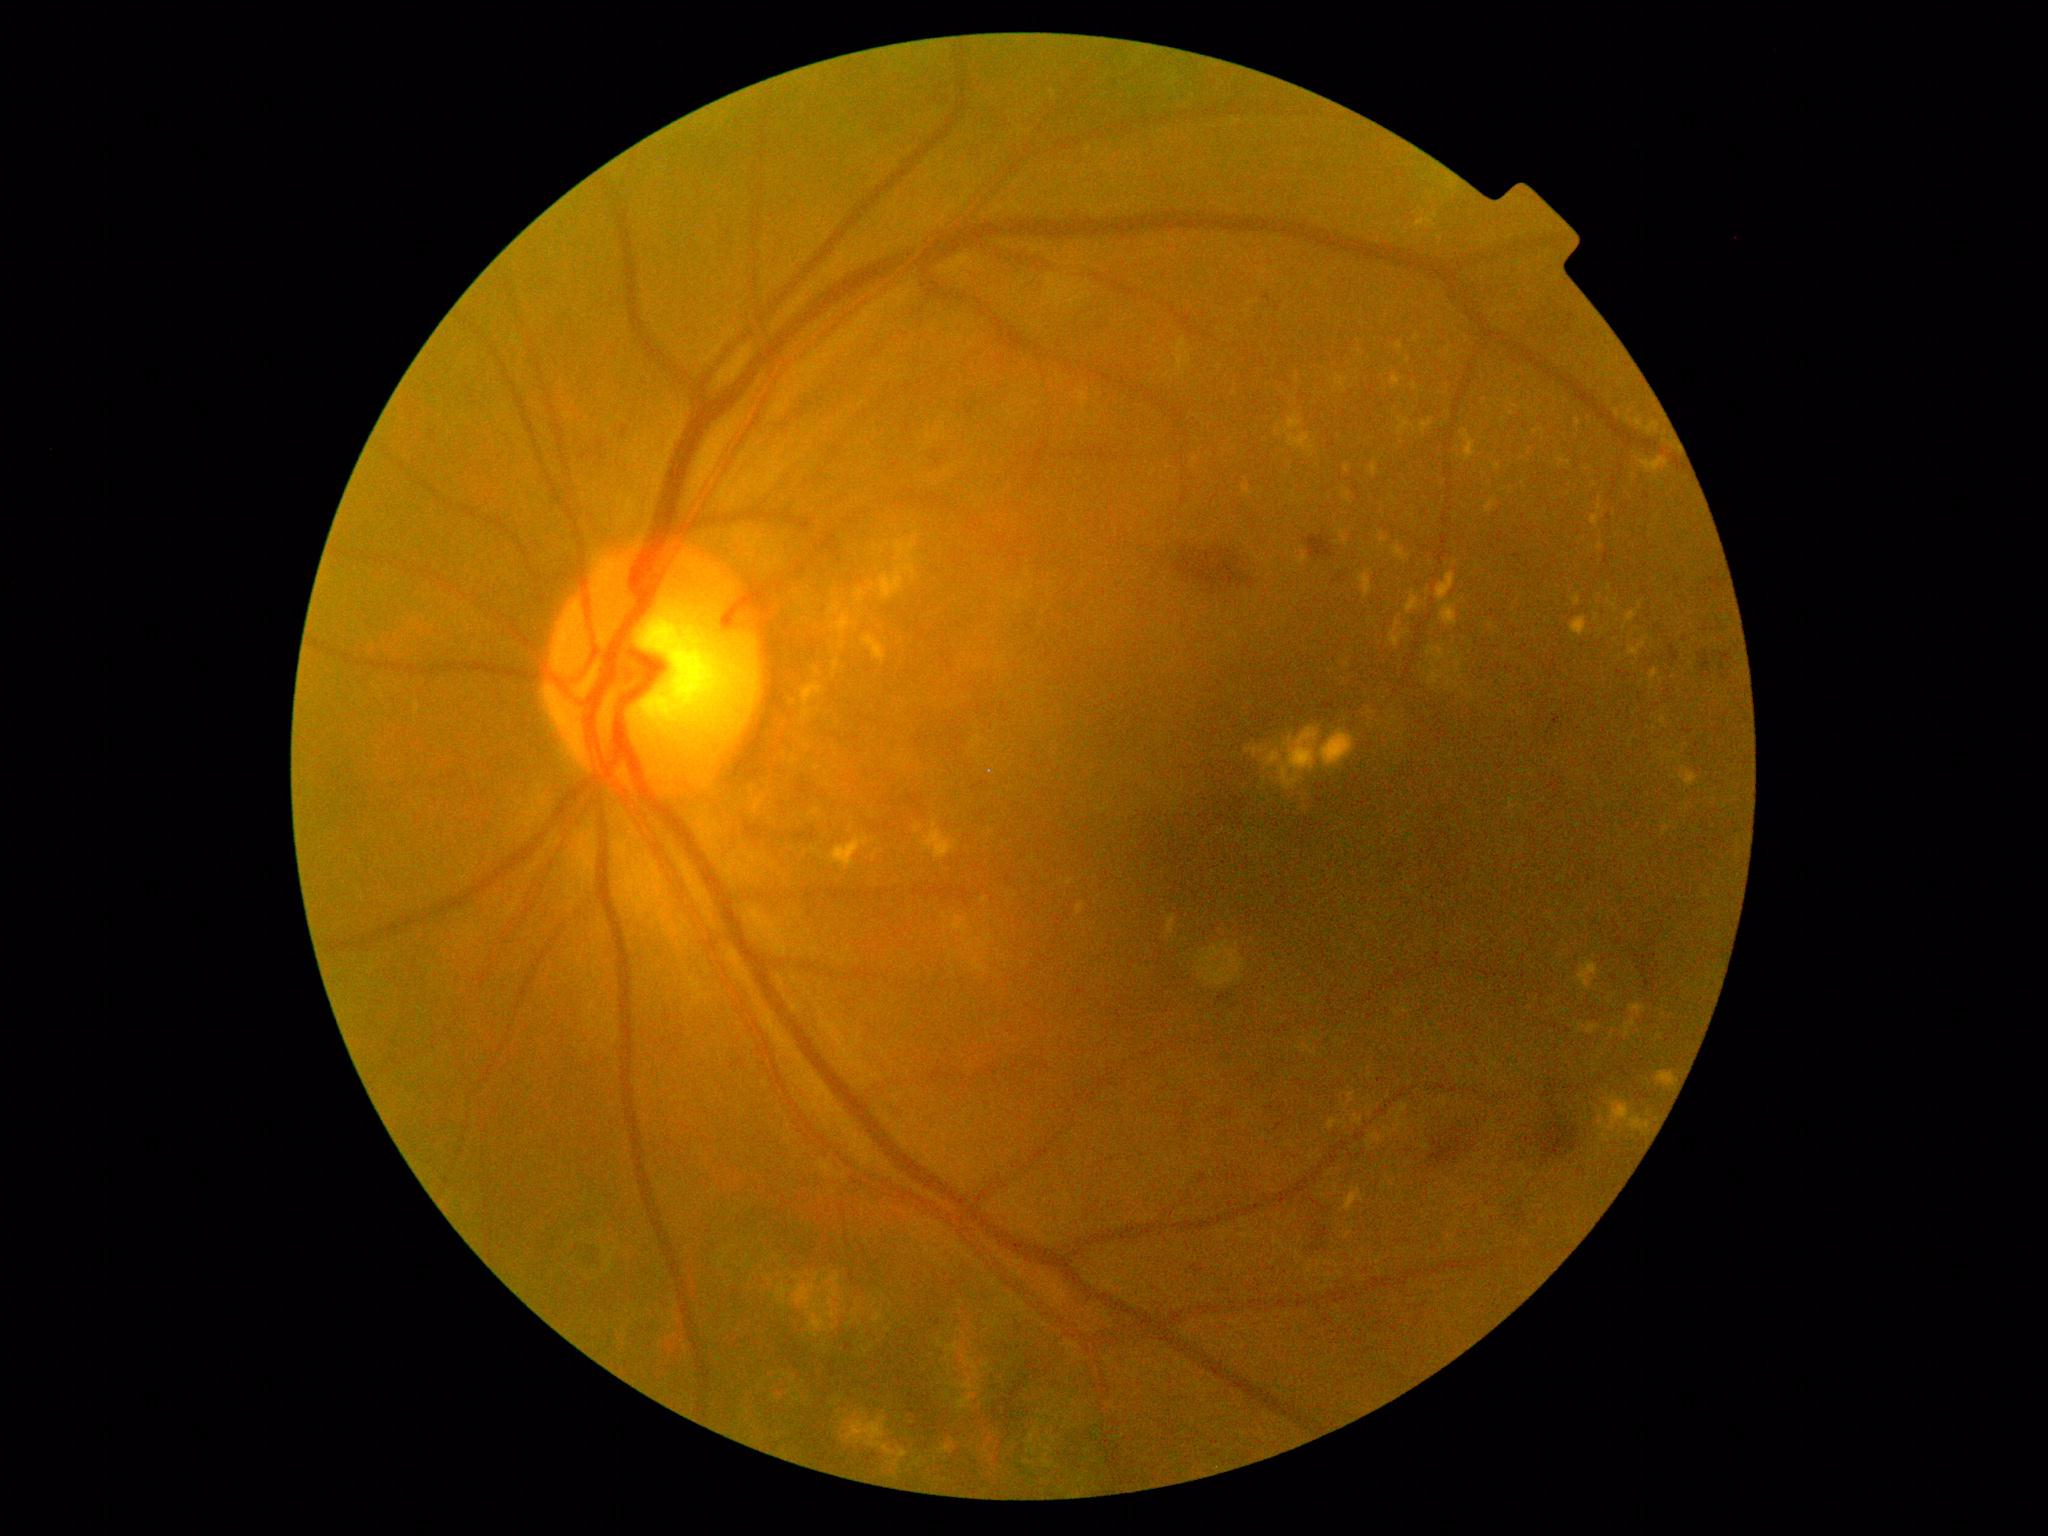
{"partial":true,"dr_grade":2,"lesions":{"he":[[1238,579,1244,590],[1669,644,1679,663],[1267,1105,1275,1111],[1696,644,1737,682],[1499,1194,1524,1230],[1212,991,1239,1017],[1378,1078,1387,1083],[1247,577,1255,590],[1221,1108,1235,1118],[1429,1113,1483,1168]],"he_small_centers":[[1279,308]],"ex":[[1396,1104,1408,1134],[1371,465,1378,477],[1662,820,1673,835],[1335,530,1350,546],[808,709,812,717],[1575,418,1582,427],[1679,766,1699,788],[1638,457,1671,474],[1572,594,1582,607],[878,533,918,600],[1353,1114,1363,1125],[1486,498,1497,514],[1629,640,1646,657],[1284,428,1314,451],[1166,915,1176,937]],"ex_small_centers":[[838,723],[1537,1000],[1602,632],[1536,432]]}}